640 by 480 pixels · wide-field fundus photograph from neonatal ROP screening.
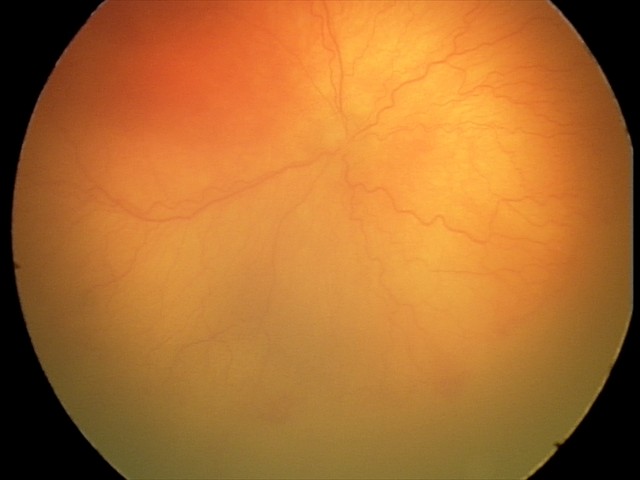

Screening series with aggressive ROP (A-ROP).